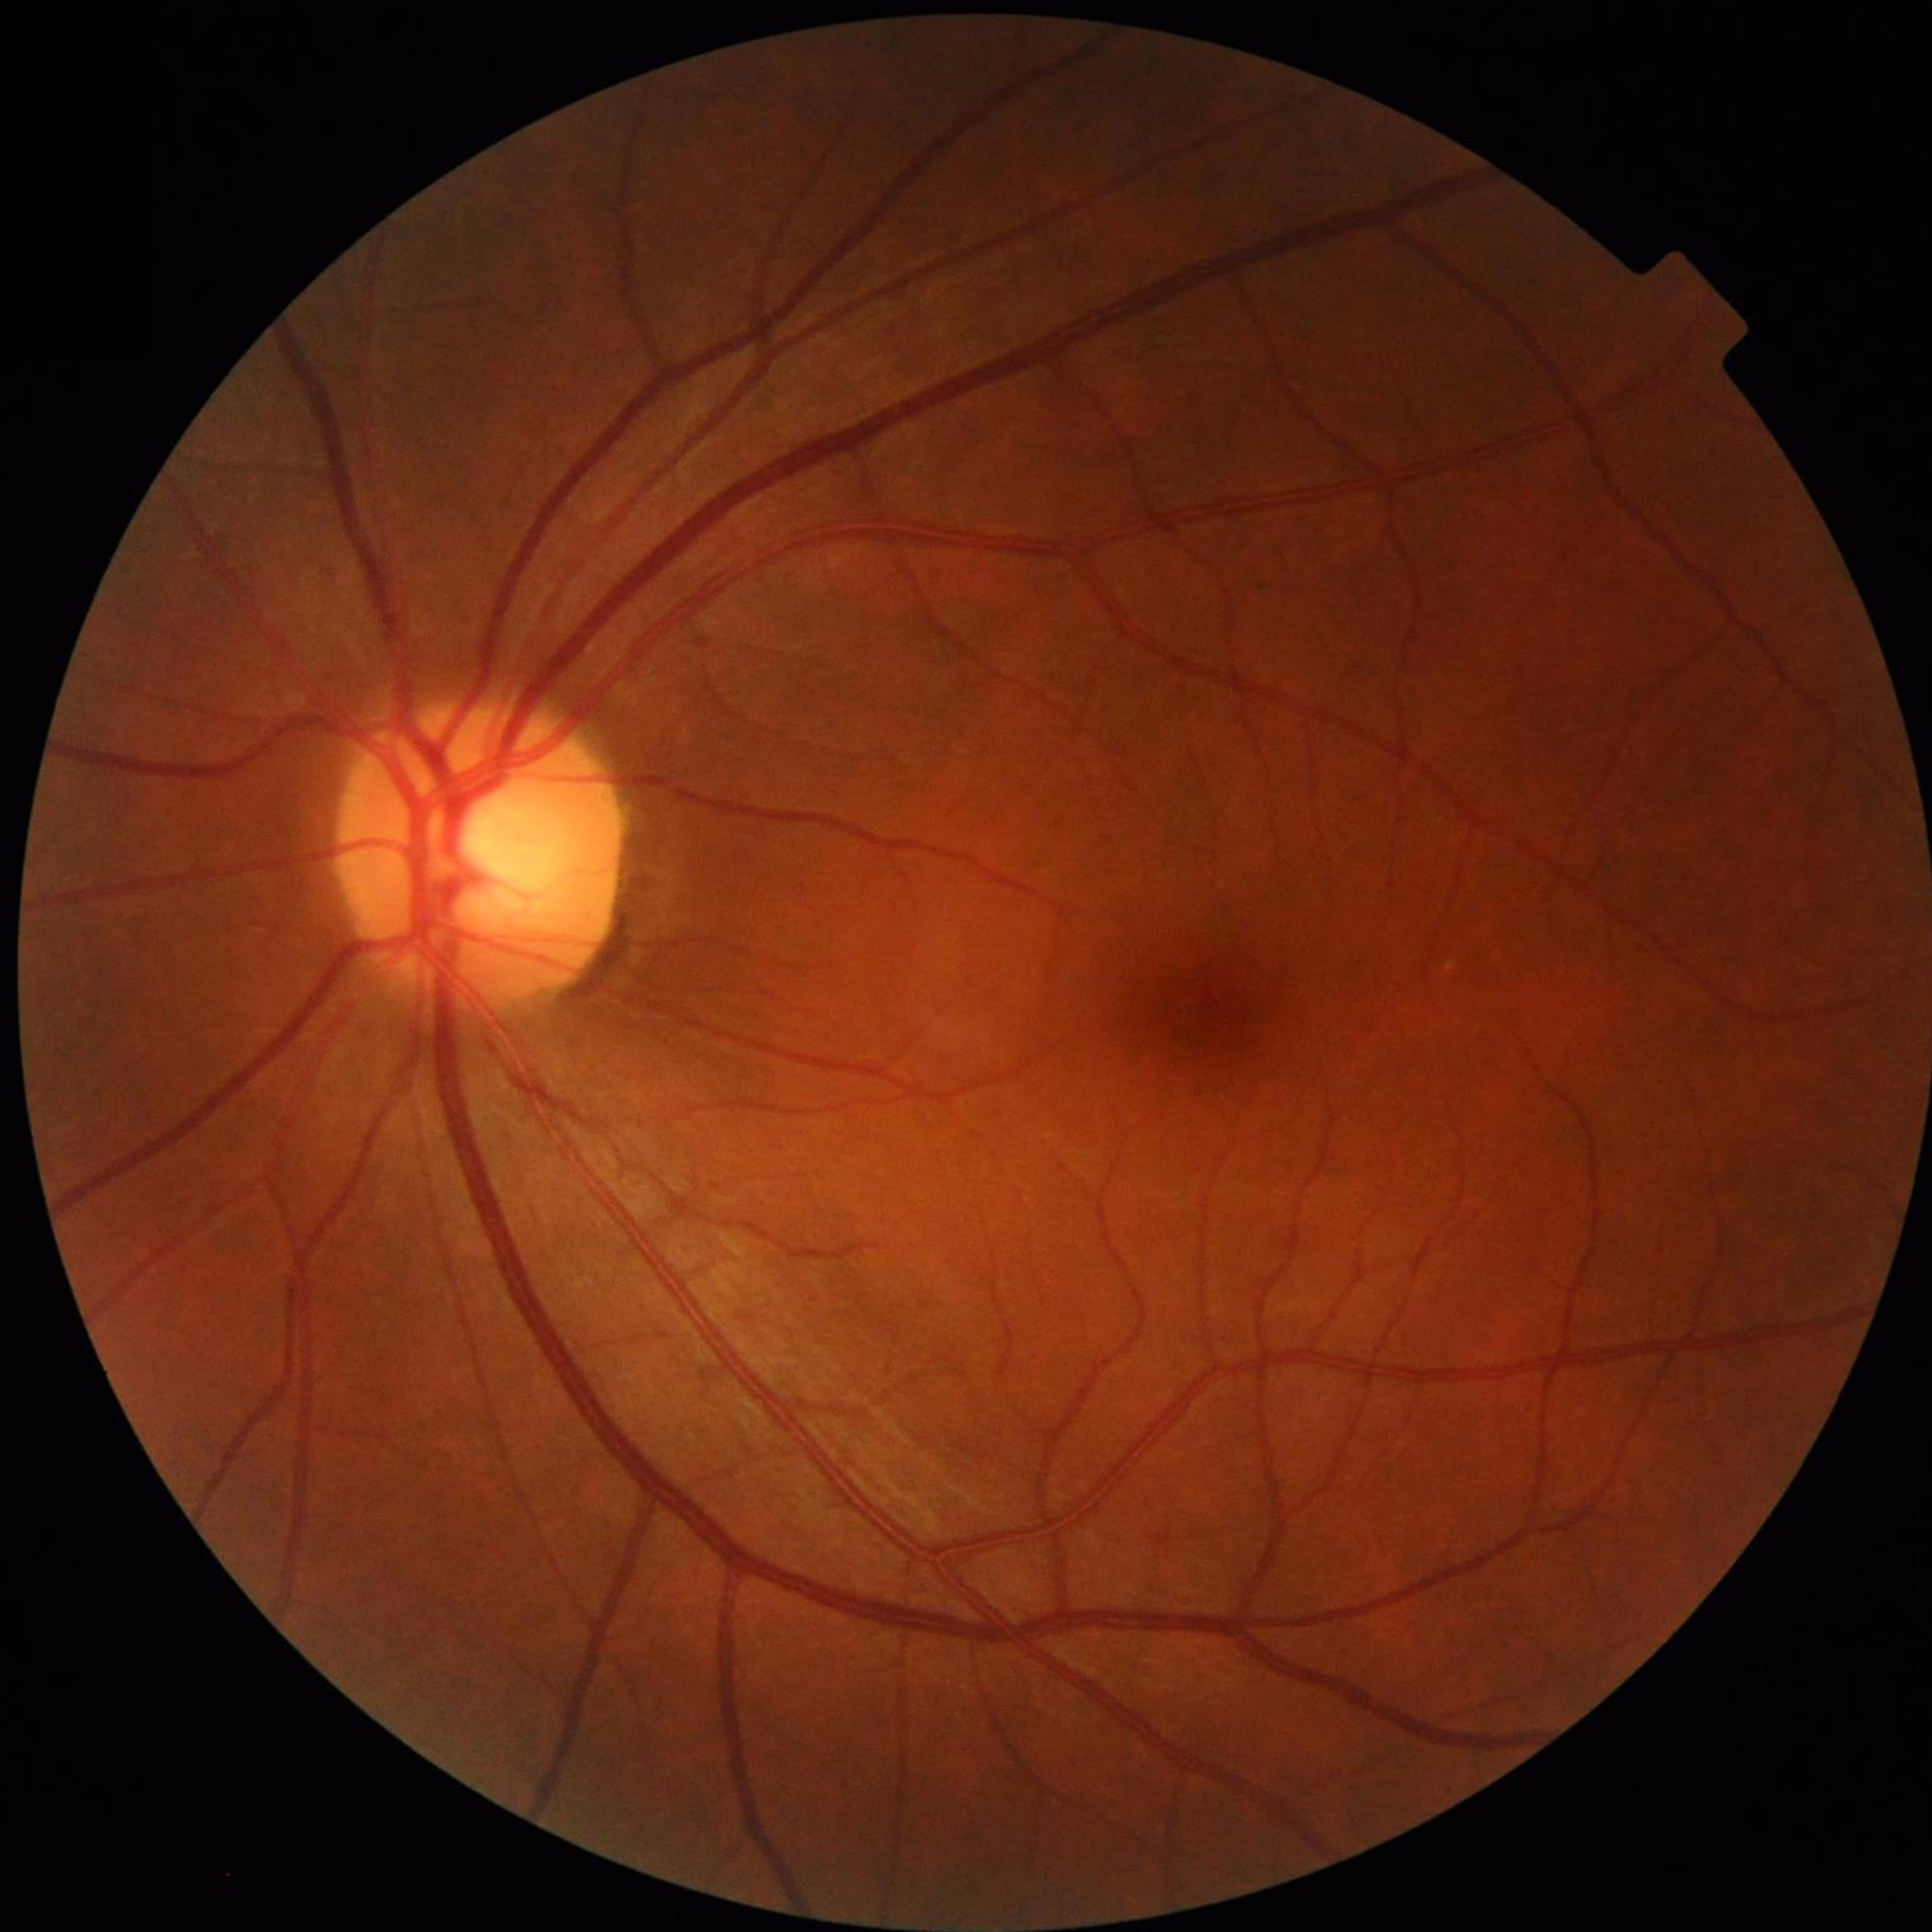
No findings of AMD, diabetic retinopathy, or glaucoma.